640 x 480 pixels. Wide-field fundus image from infant ROP screening: 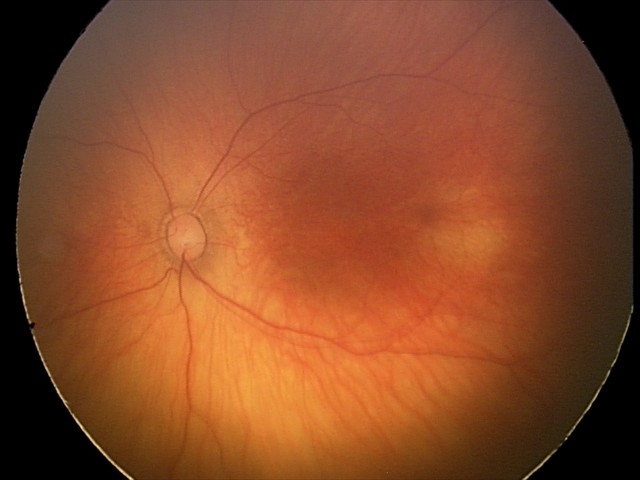

Q: What is the screening diagnosis?
A: physiological retinal finding